Fundus photo taken with a portable handheld camera. 2212 x 1659 pixels: 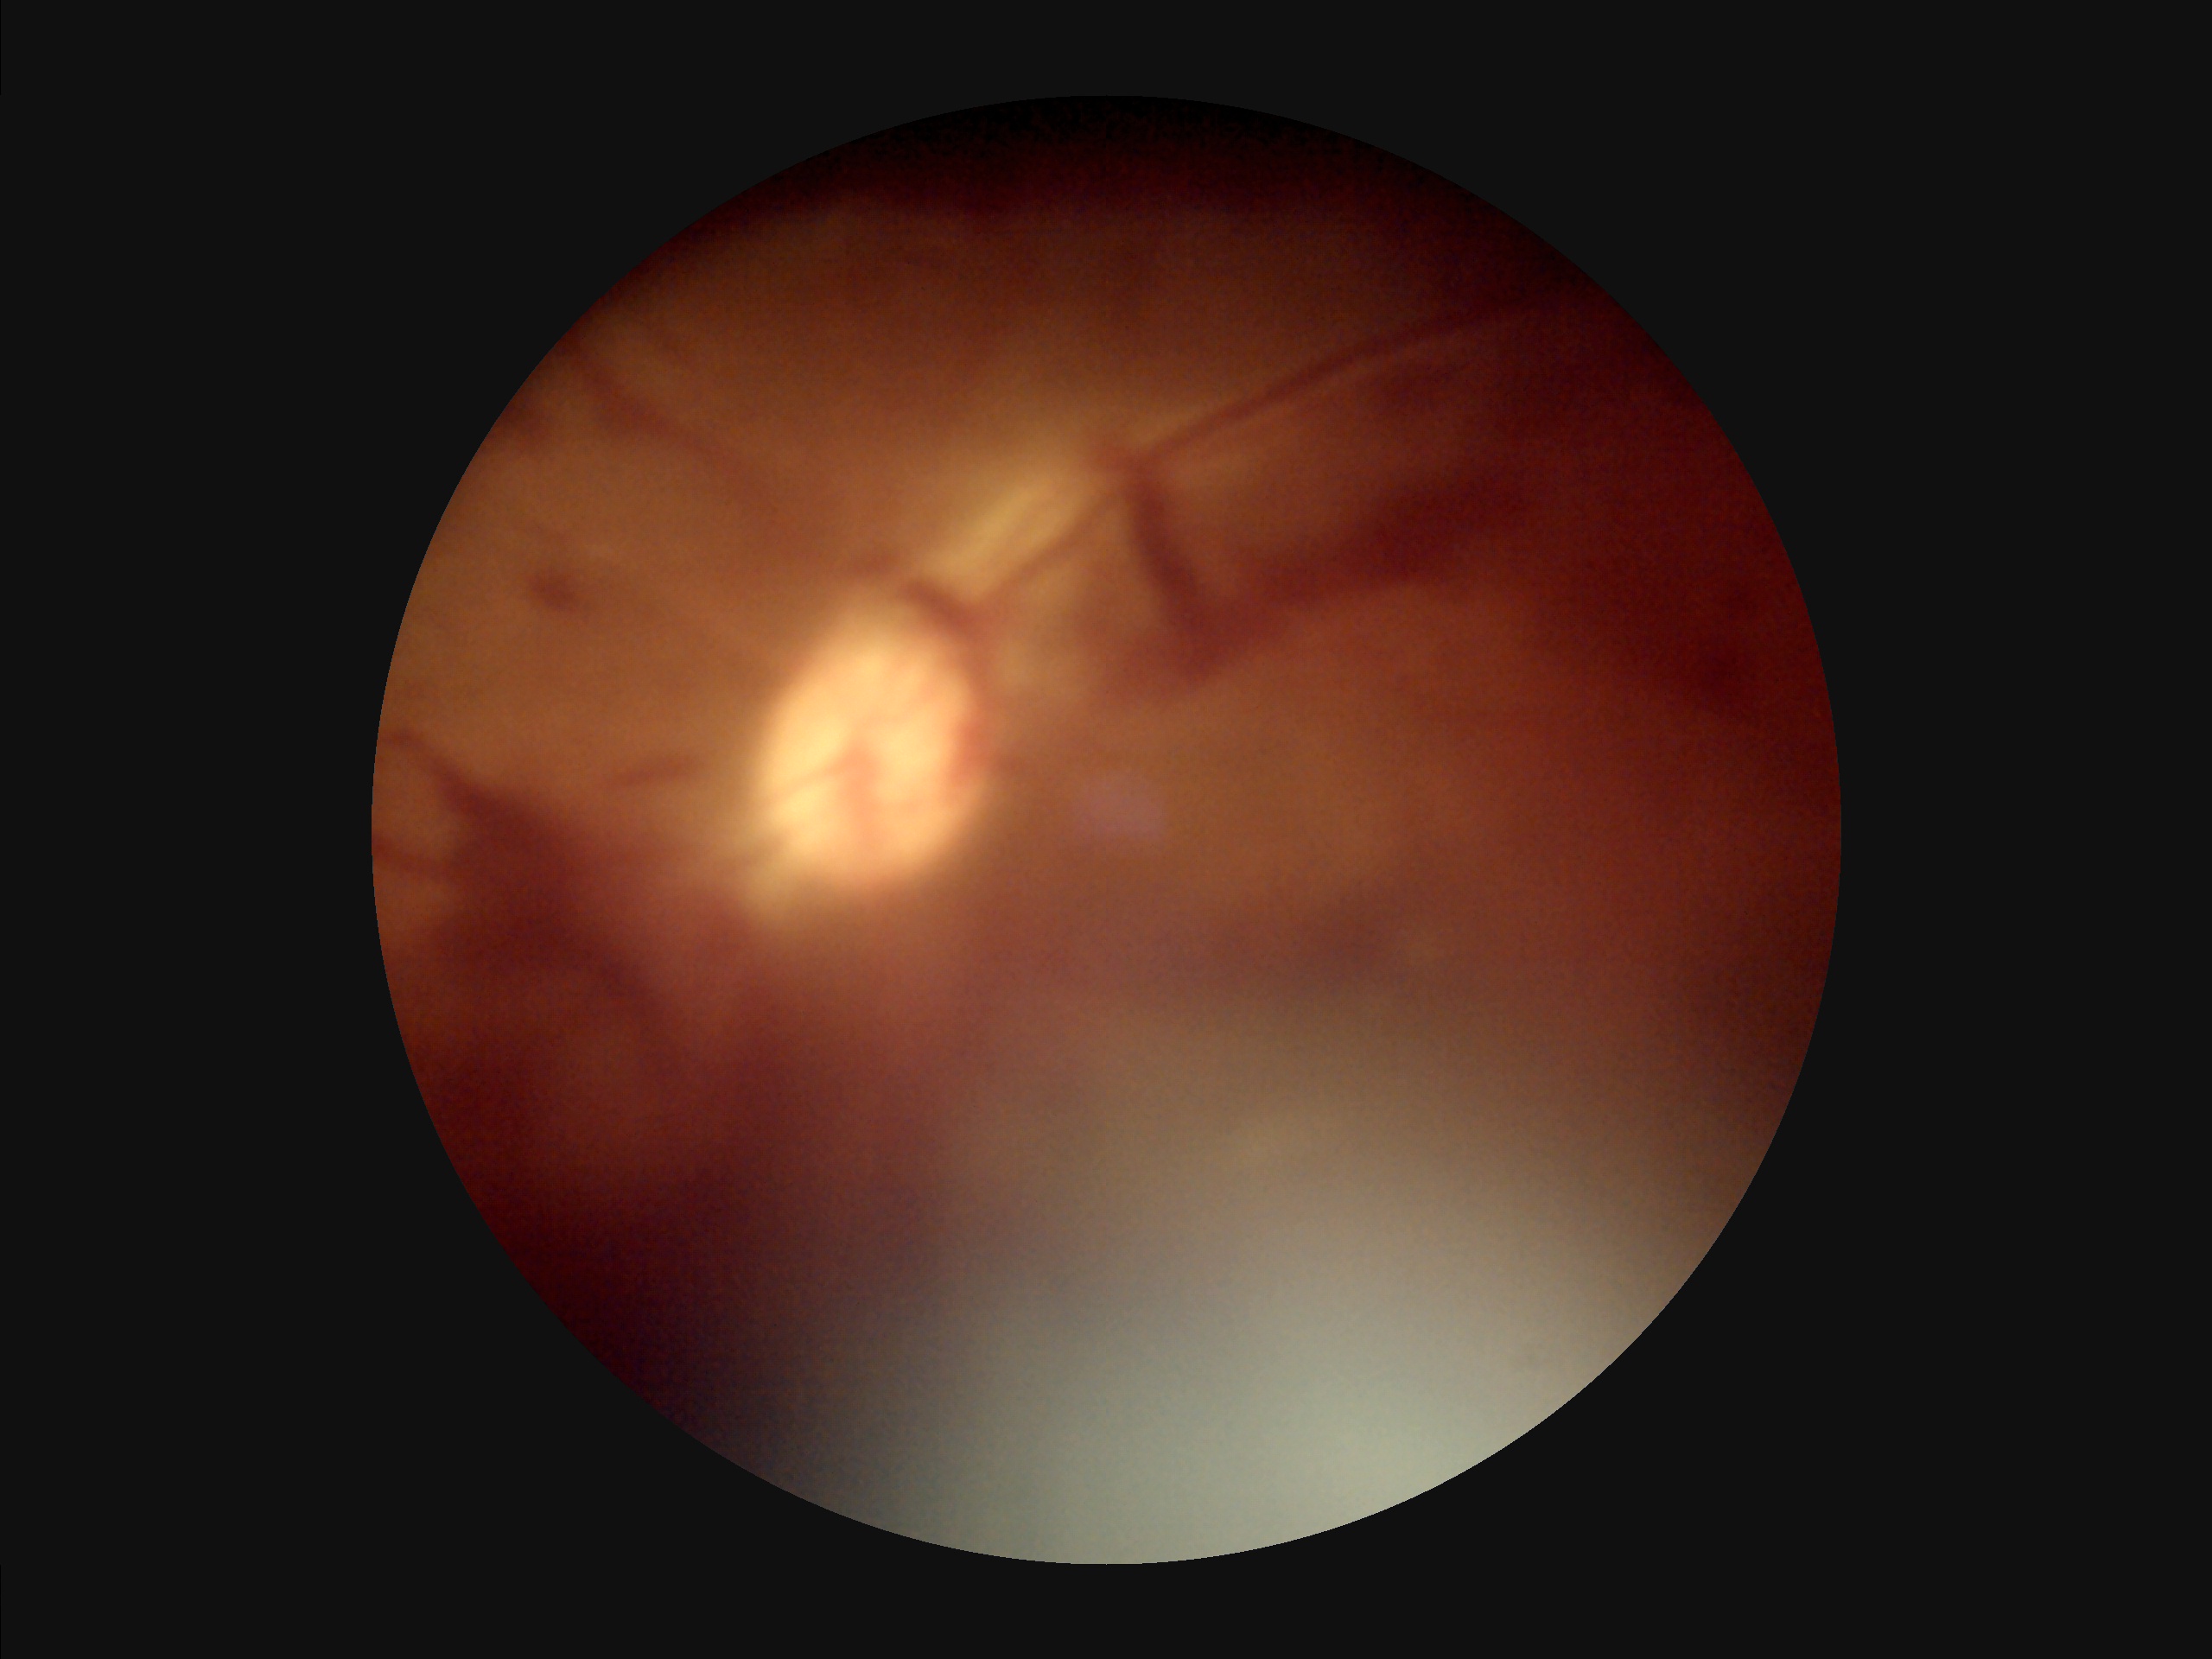

  contrast: poor
  clarity: reduced
  illumination: suboptimal
  overall_quality: suboptimal